NIDEK AFC-230 fundus camera. Fundus photo: 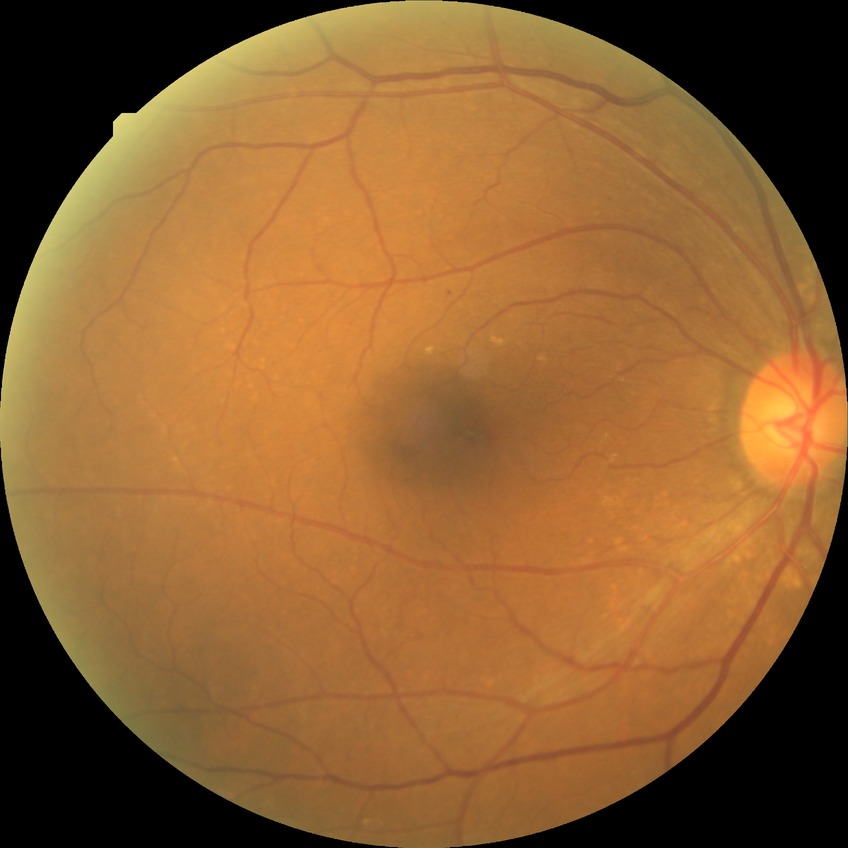 Diabetic retinopathy (DR) is NDR (no diabetic retinopathy).